FOV: 45 degrees:
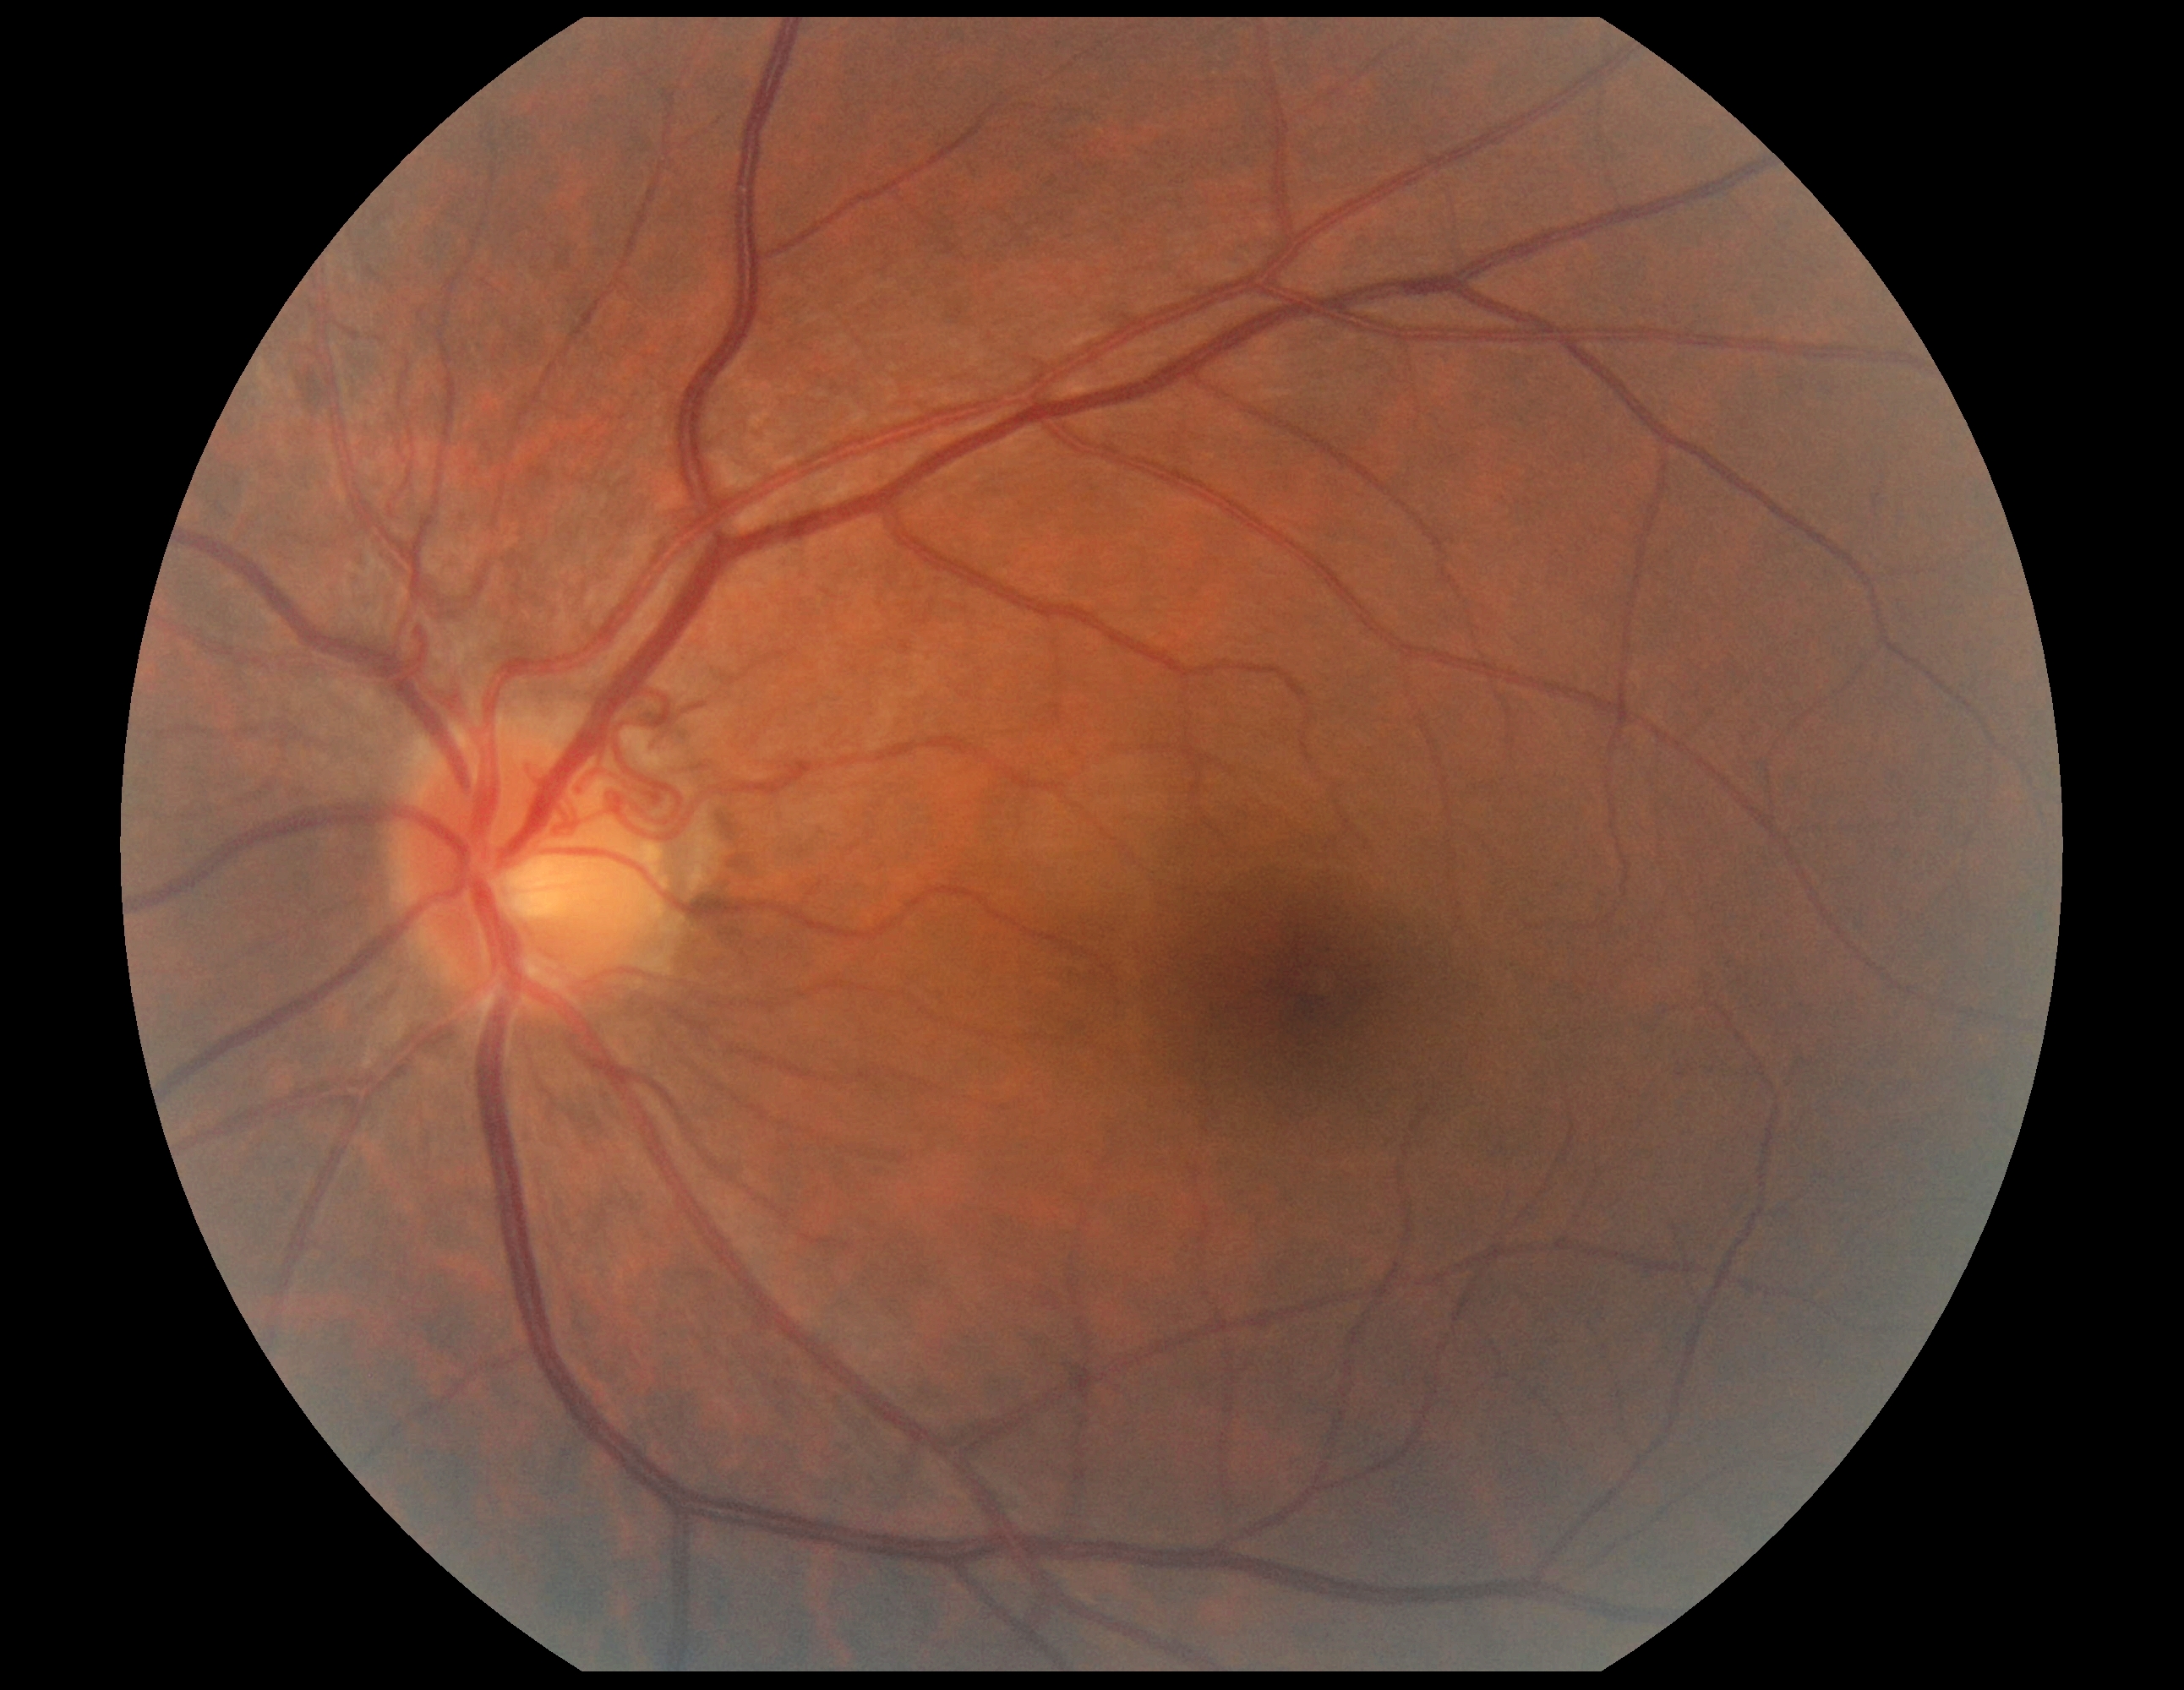

{"dr_grade": "no apparent diabetic retinopathy (grade 0) — no visible signs of diabetic retinopathy", "dr_impression": "no apparent DR"}